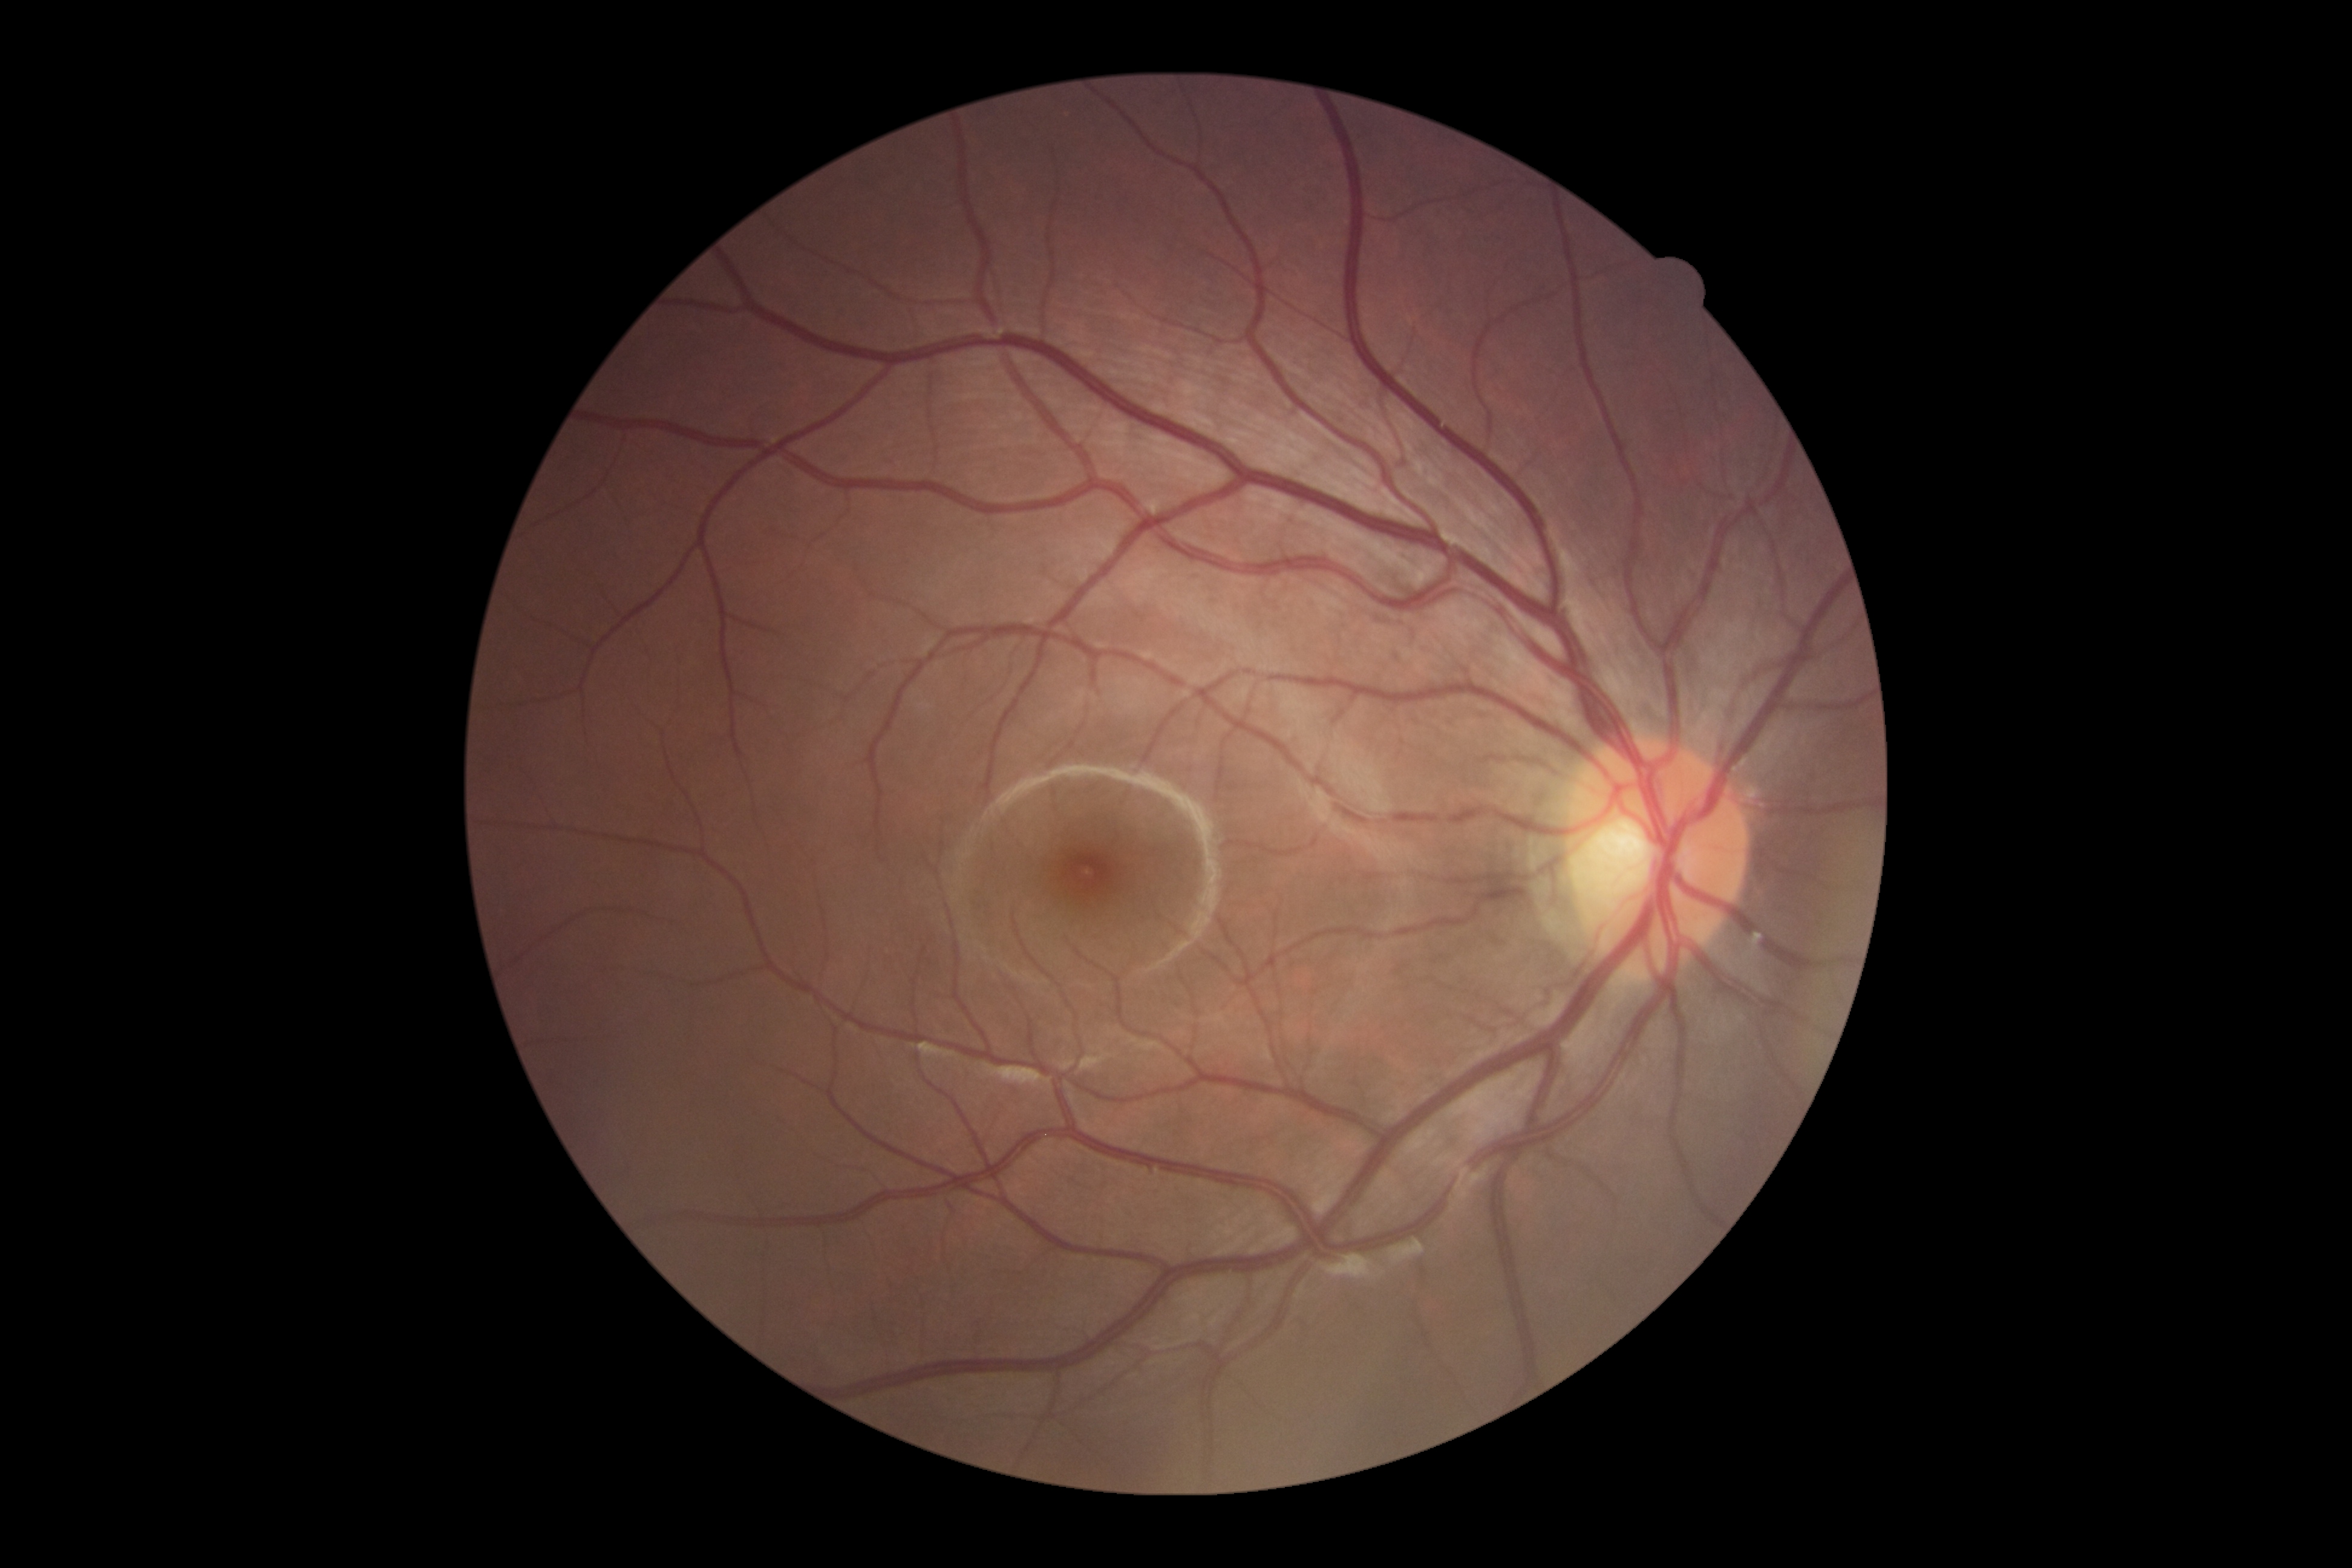

Findings:
• DR stage: grade 0 — no visible signs of diabetic retinopathy